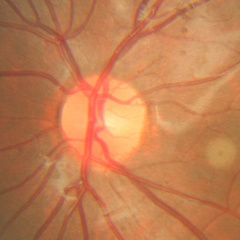

Optic disc photograph demonstrating no glaucomatous findings.